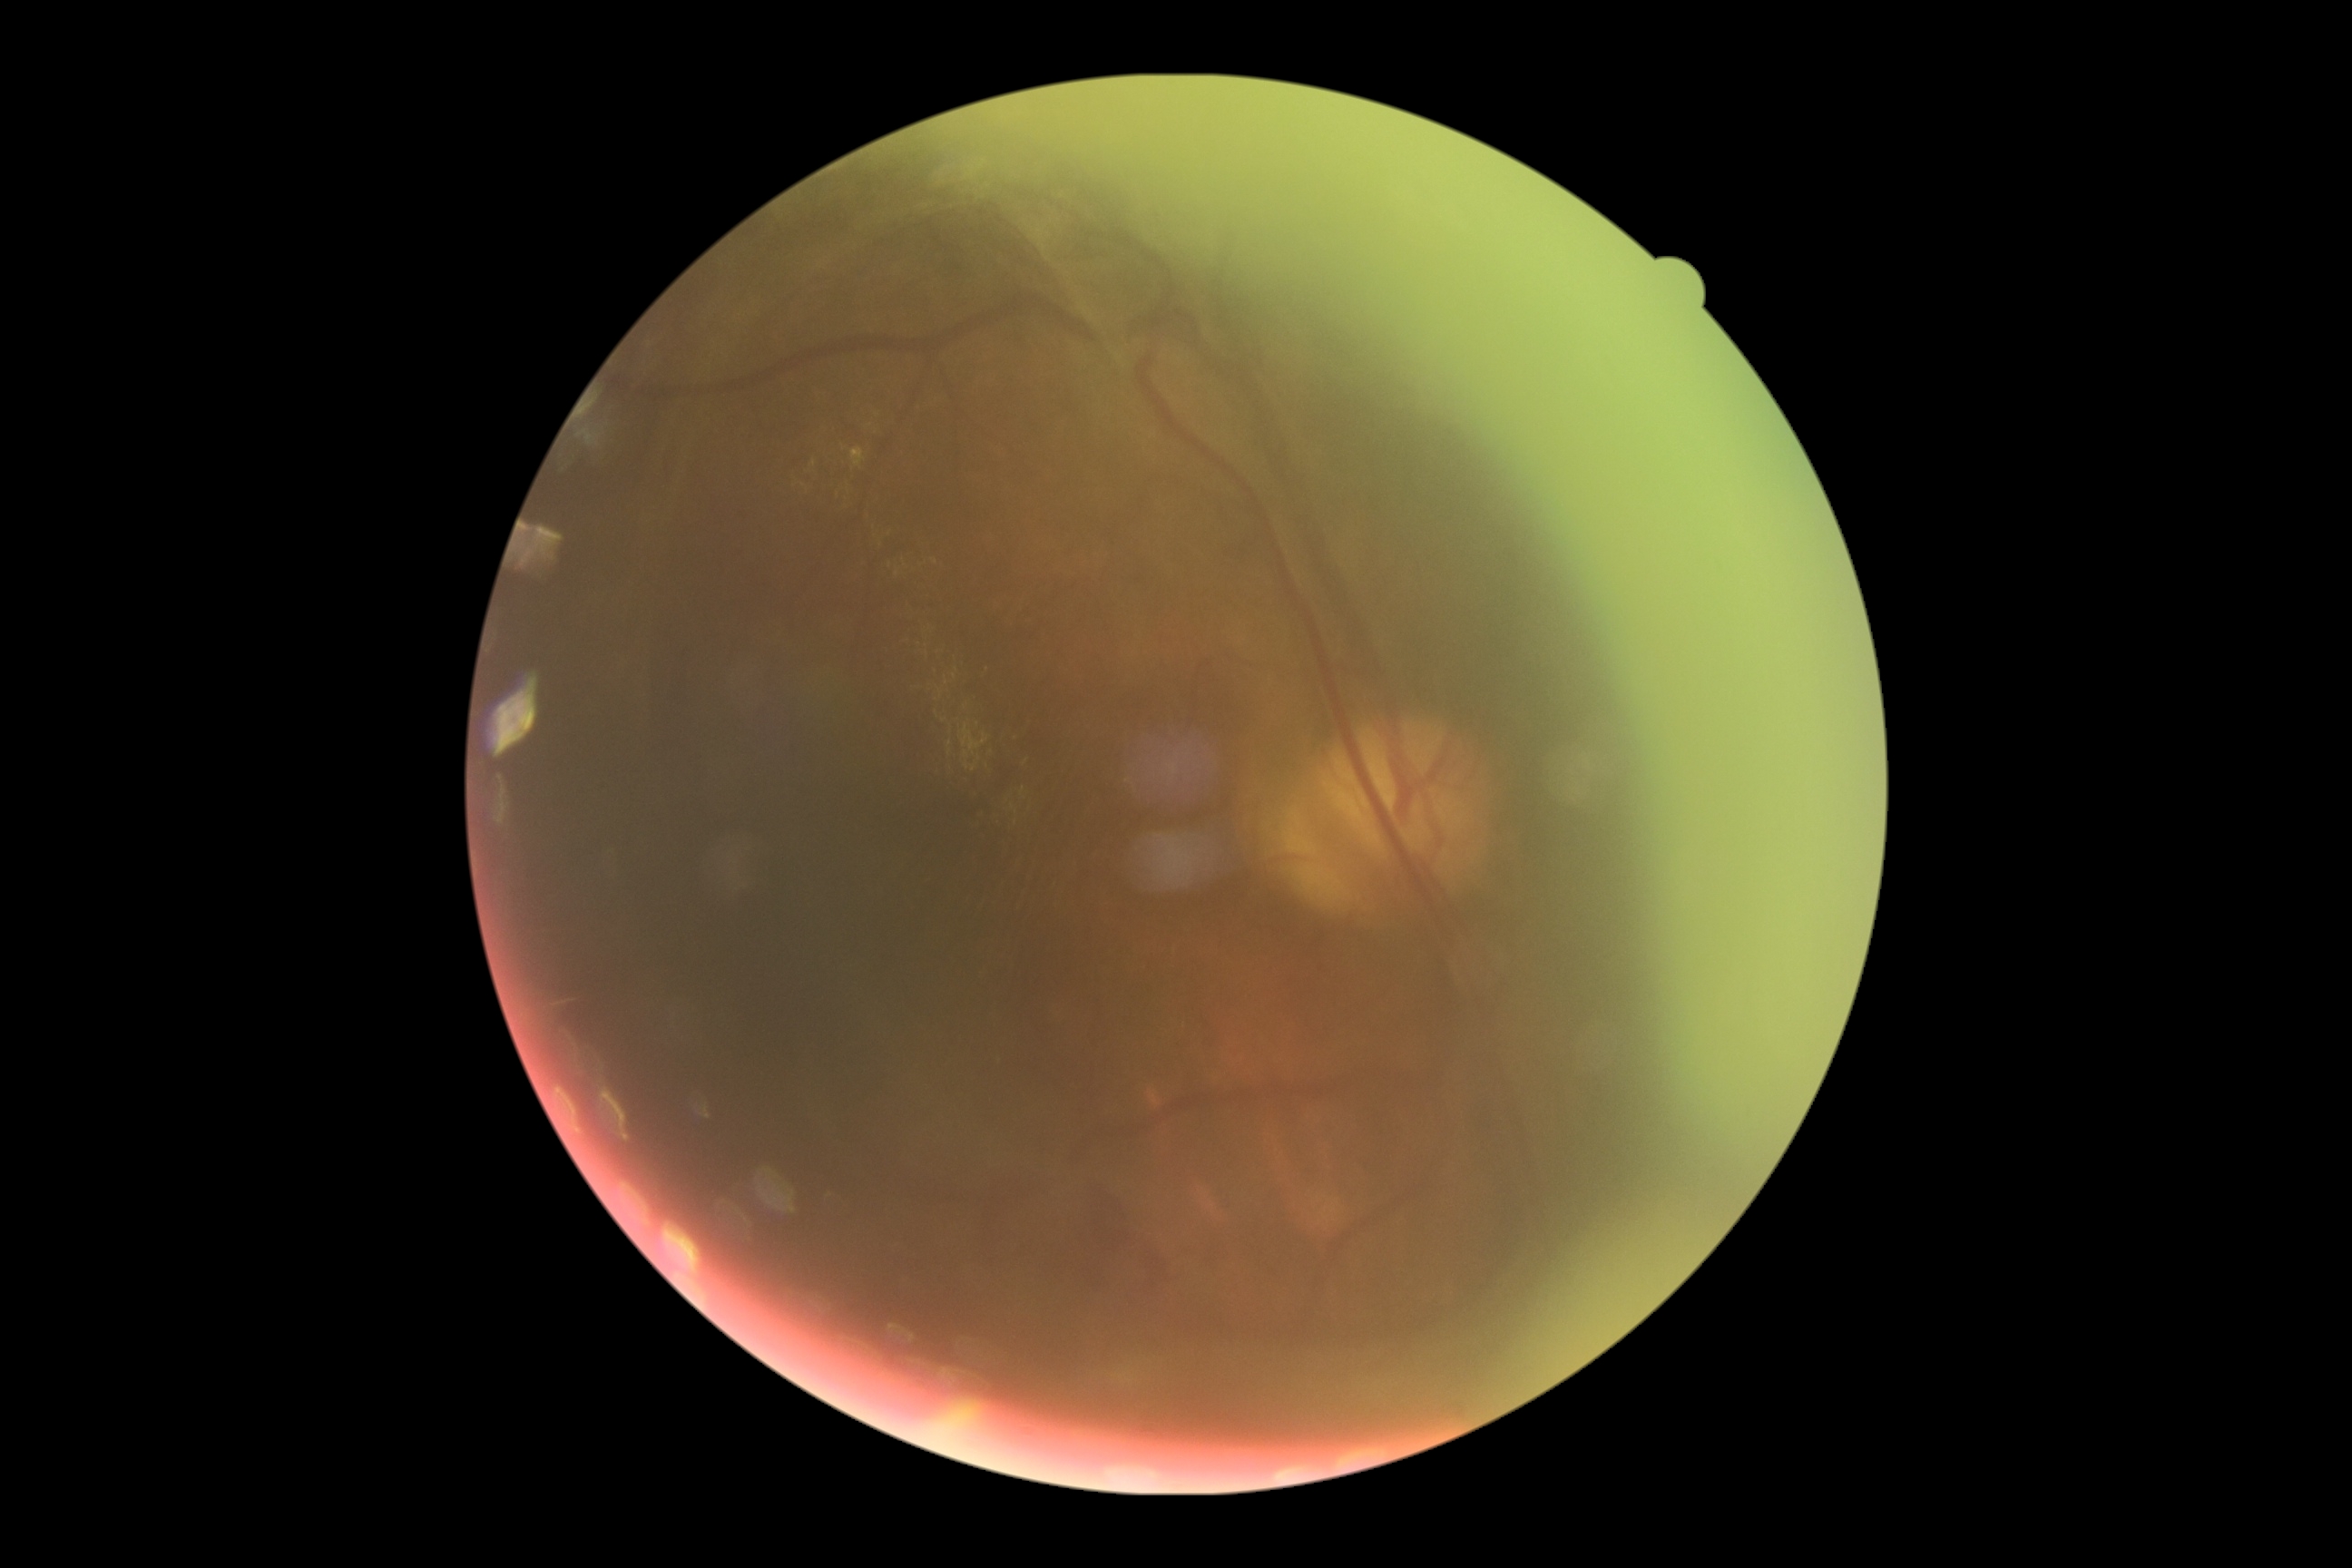

Diabetic retinopathy (DR) is grade 4.